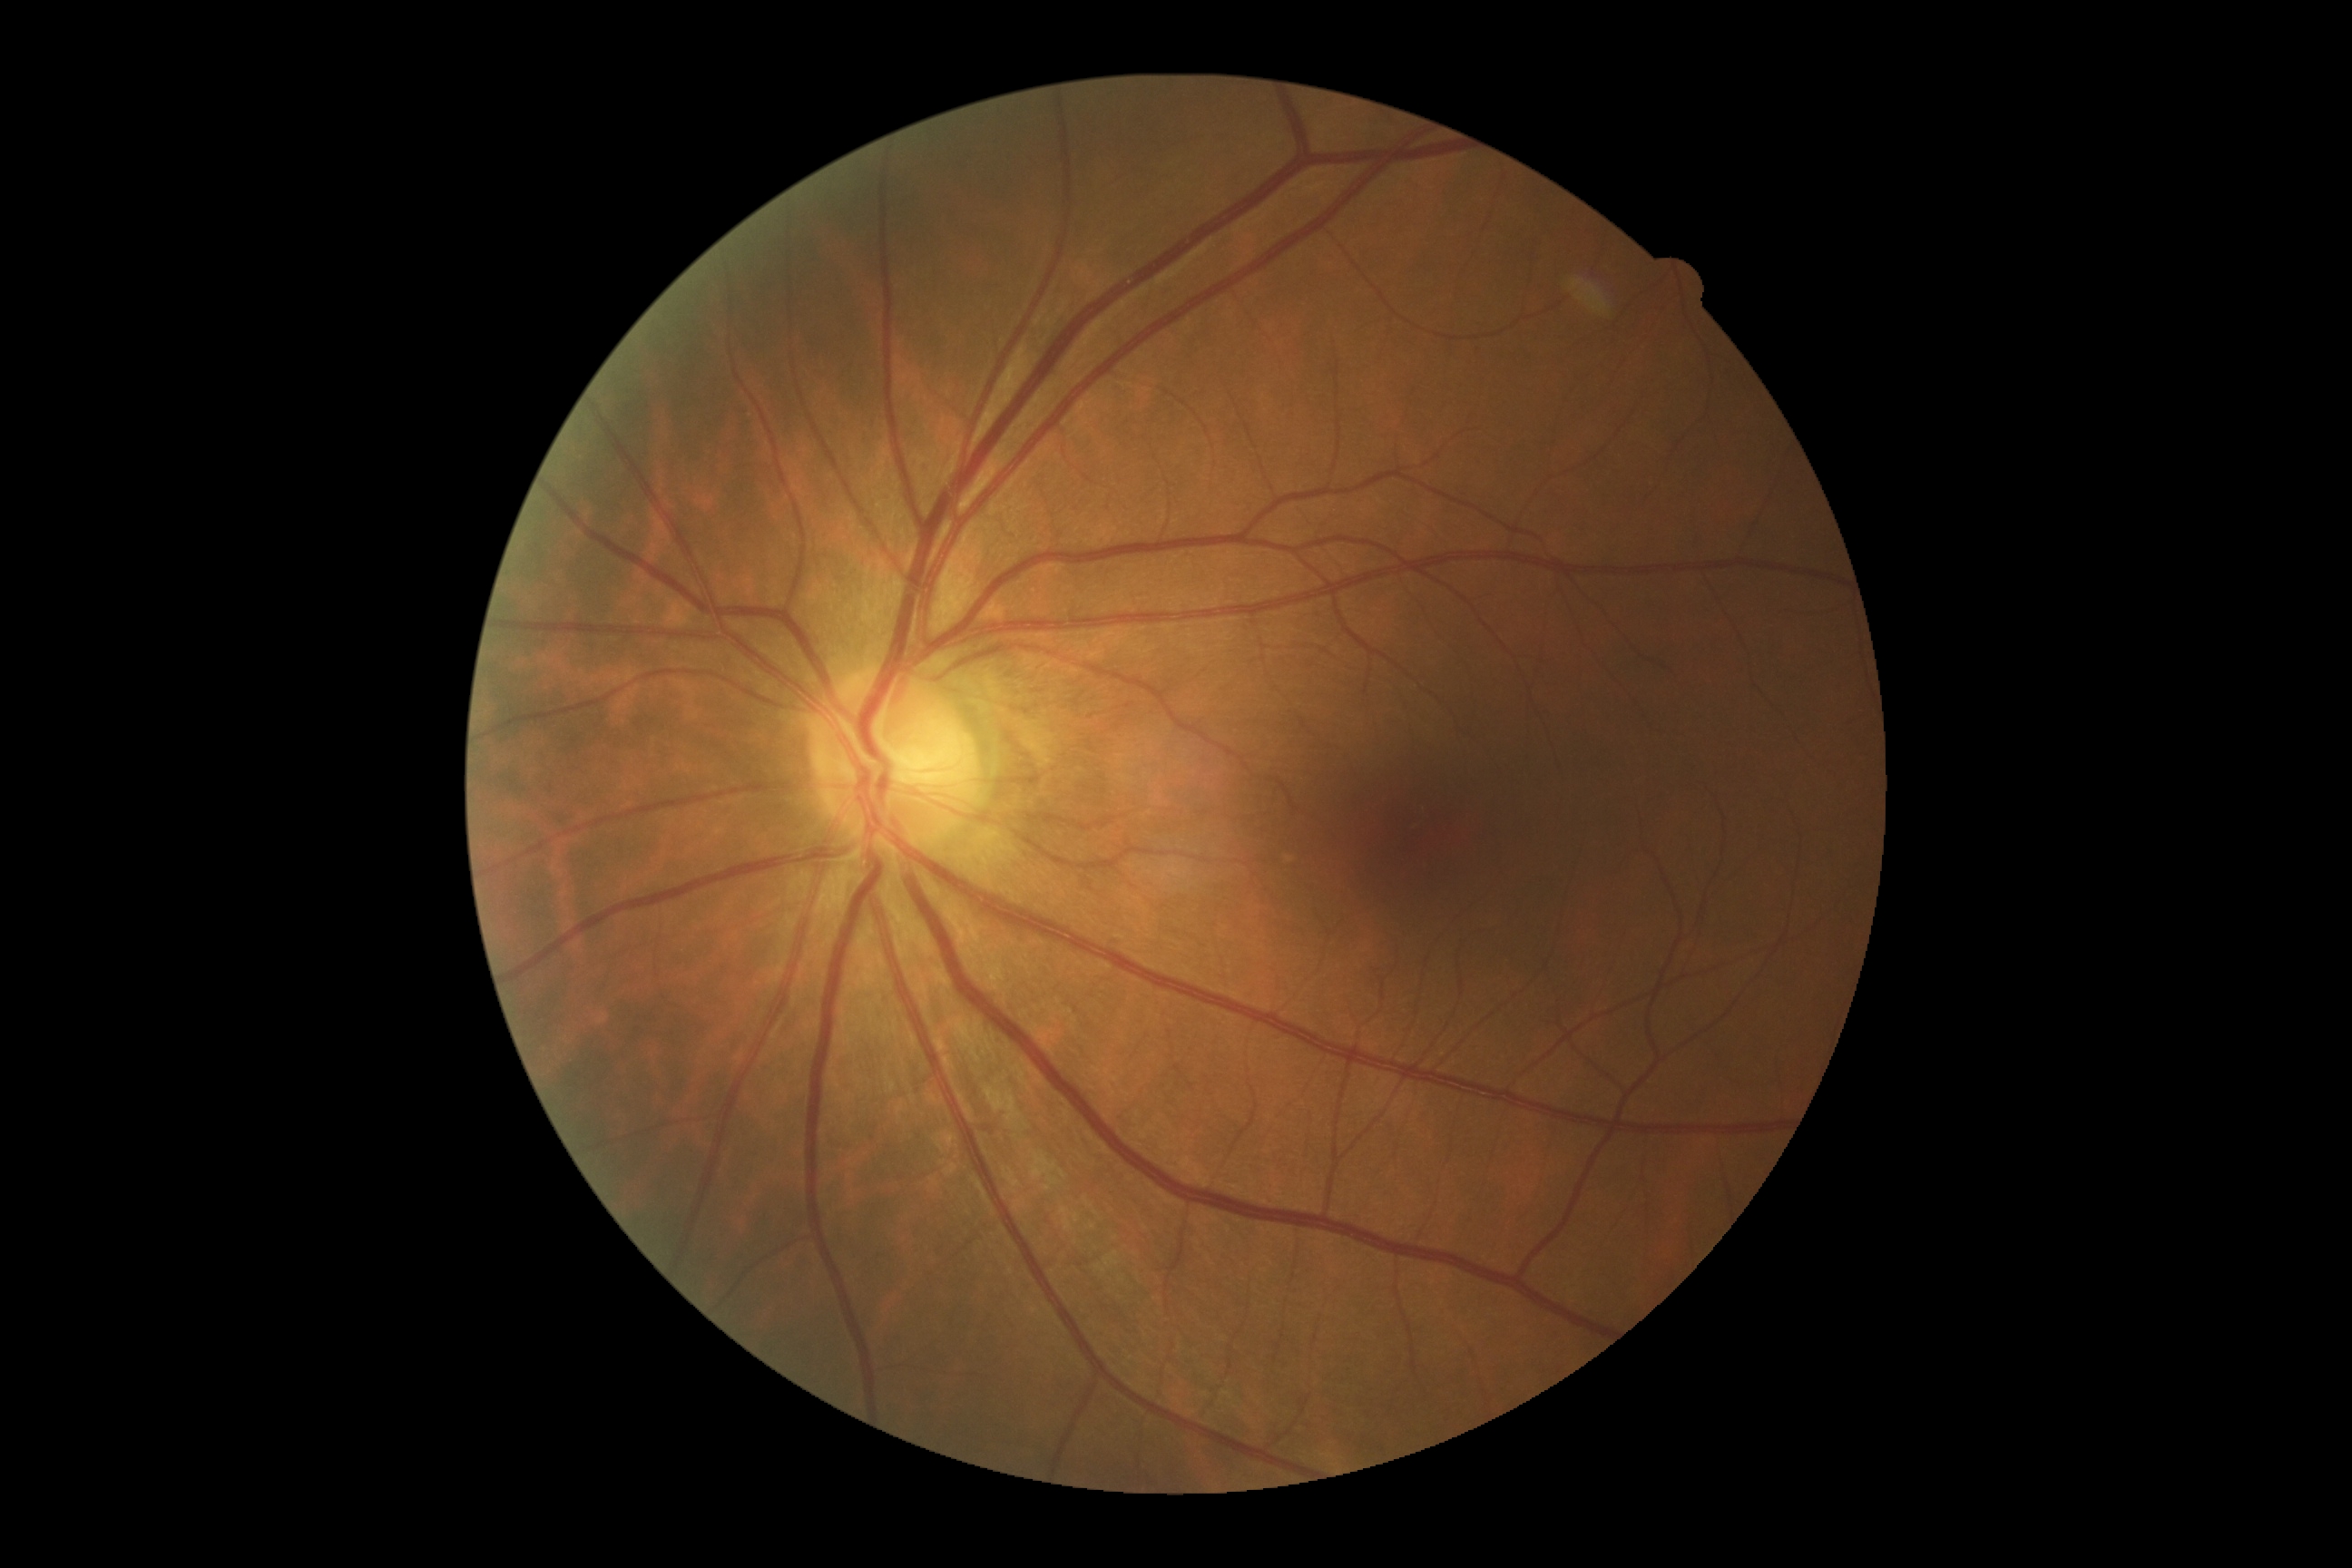
DR stage: grade 0 — no visible signs of diabetic retinopathy.